Color fundus image. 1924 x 1556 pixels
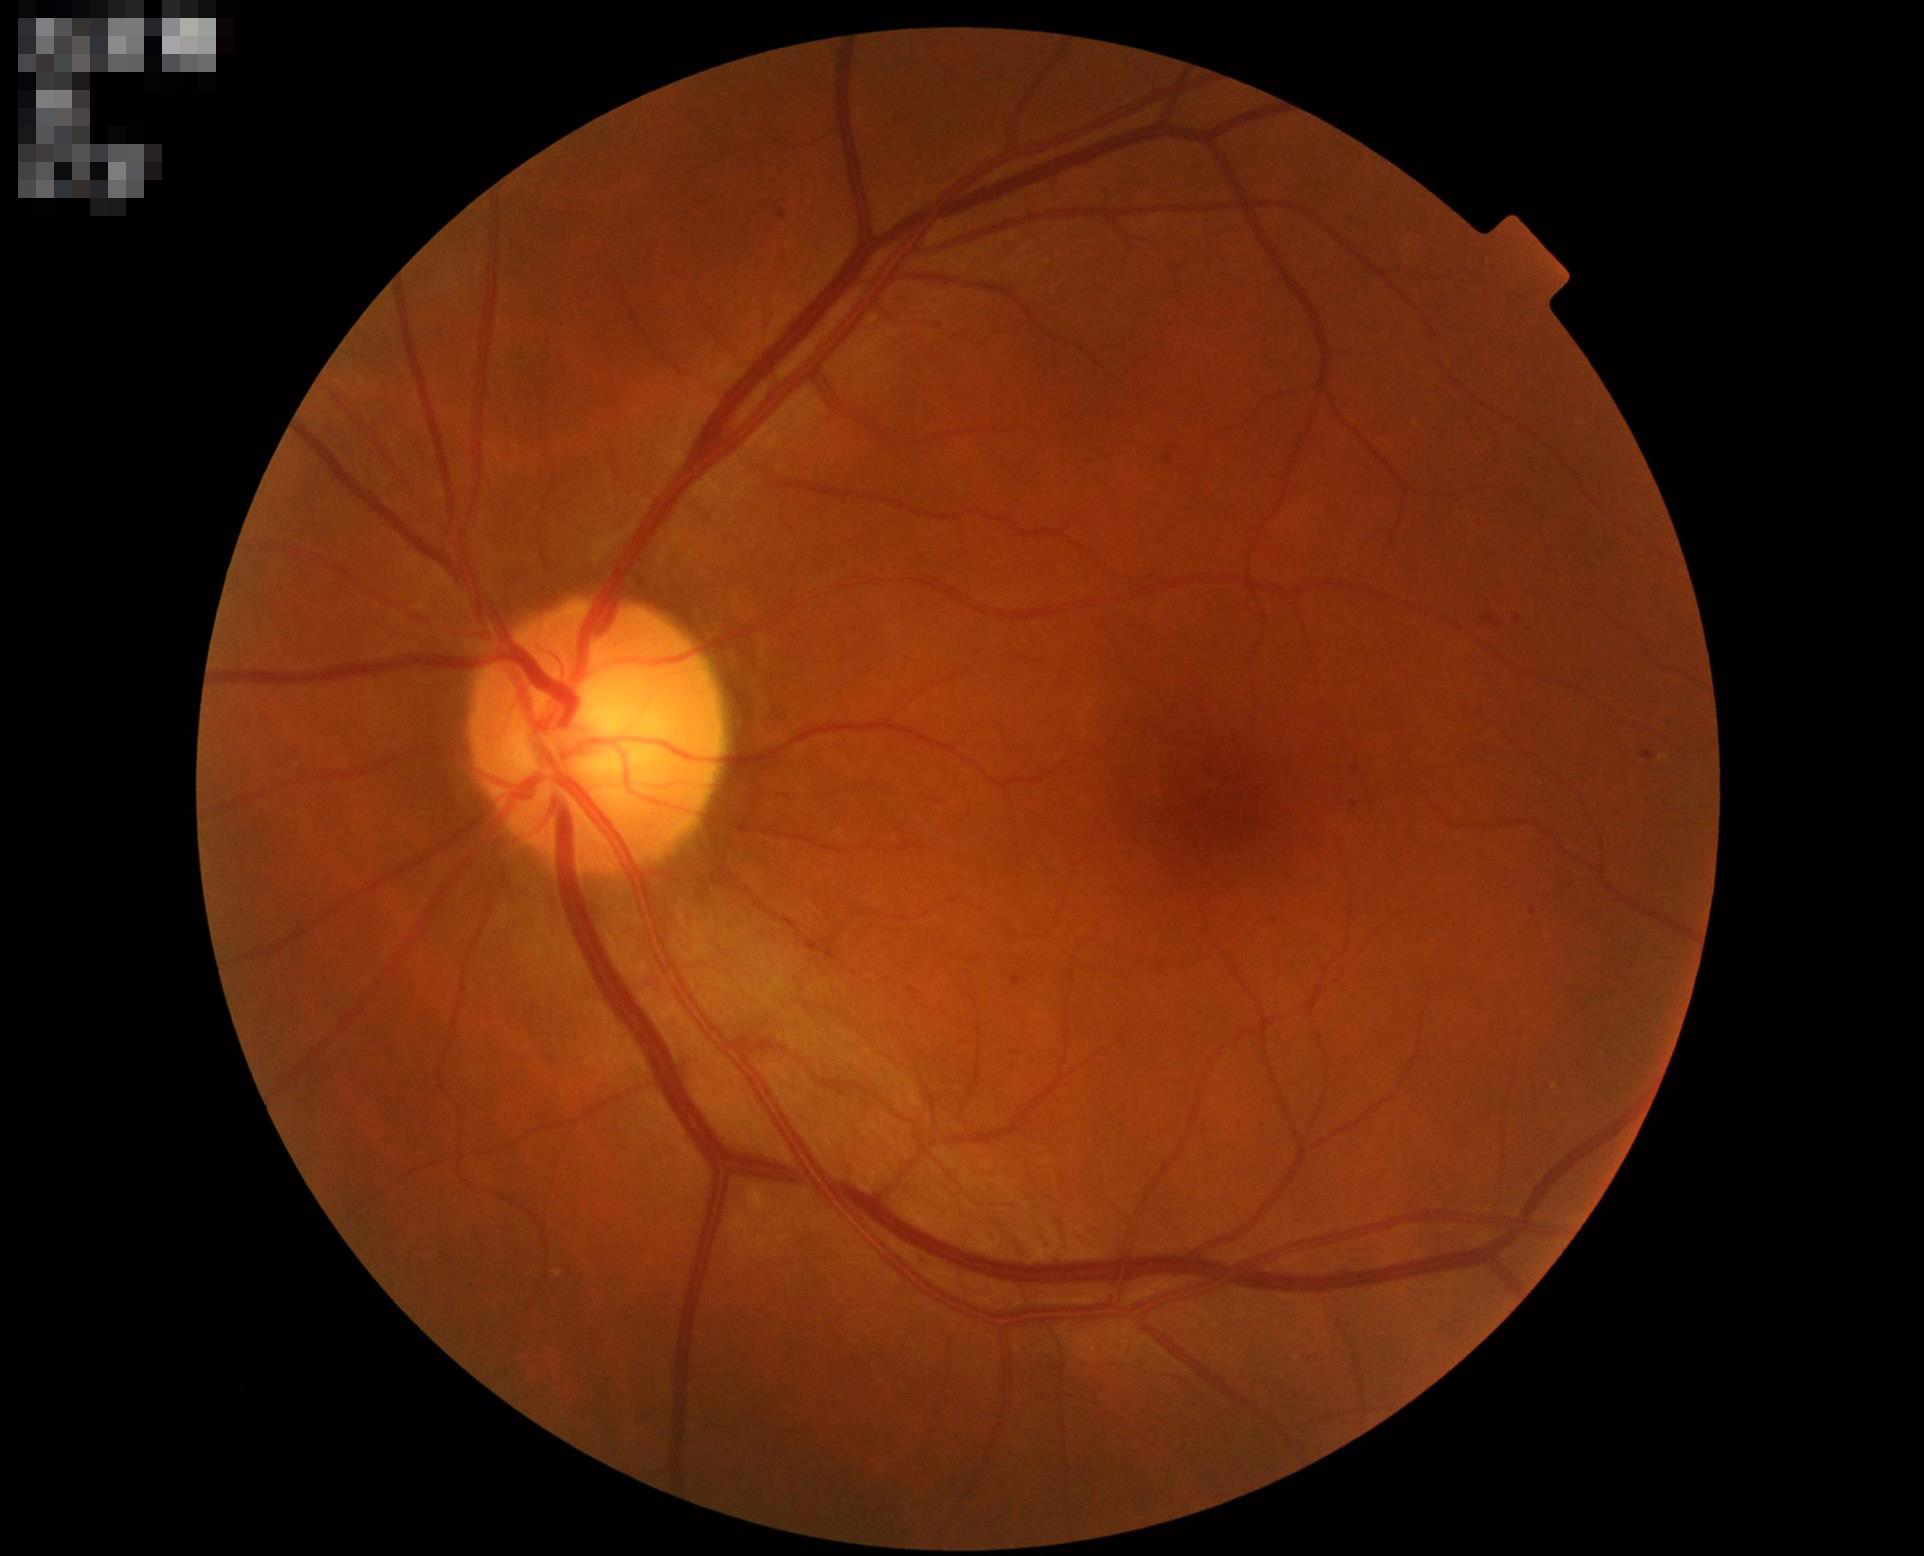 Good dynamic range.
Image quality is adequate for diagnostic use.
Optic disc, vessels, and background are in focus.